Nonmydriatic. Camera: NIDEK AFC-230. 45-degree field of view. Fundus photo. 848 by 848 pixels:
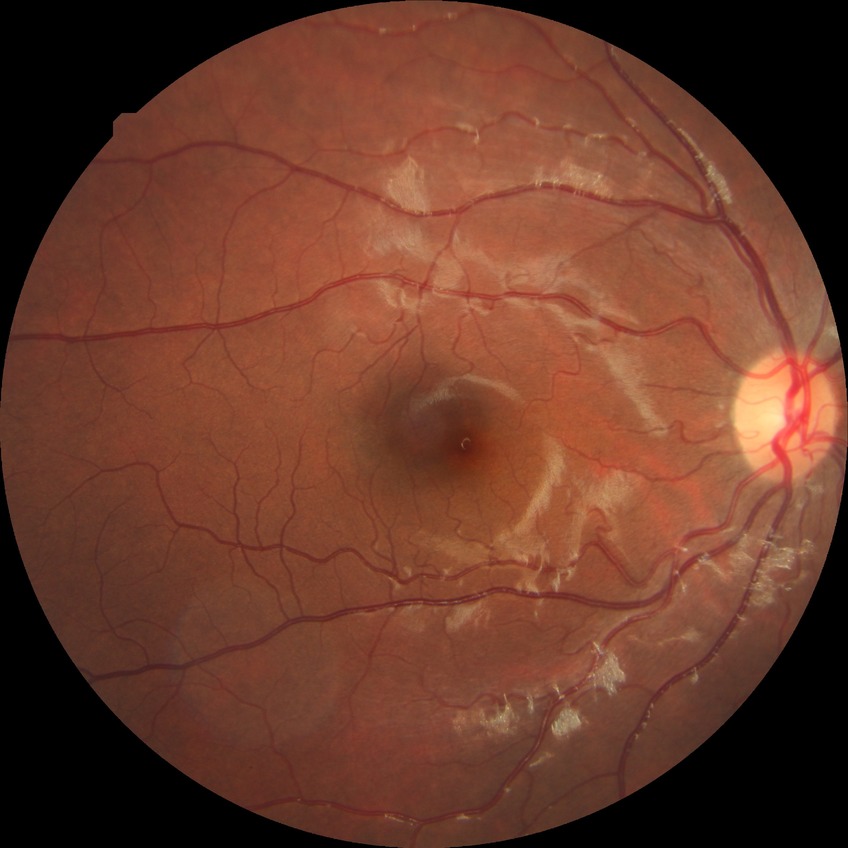
Findings:
* diabetic retinopathy severity — no diabetic retinopathy